2212x1659
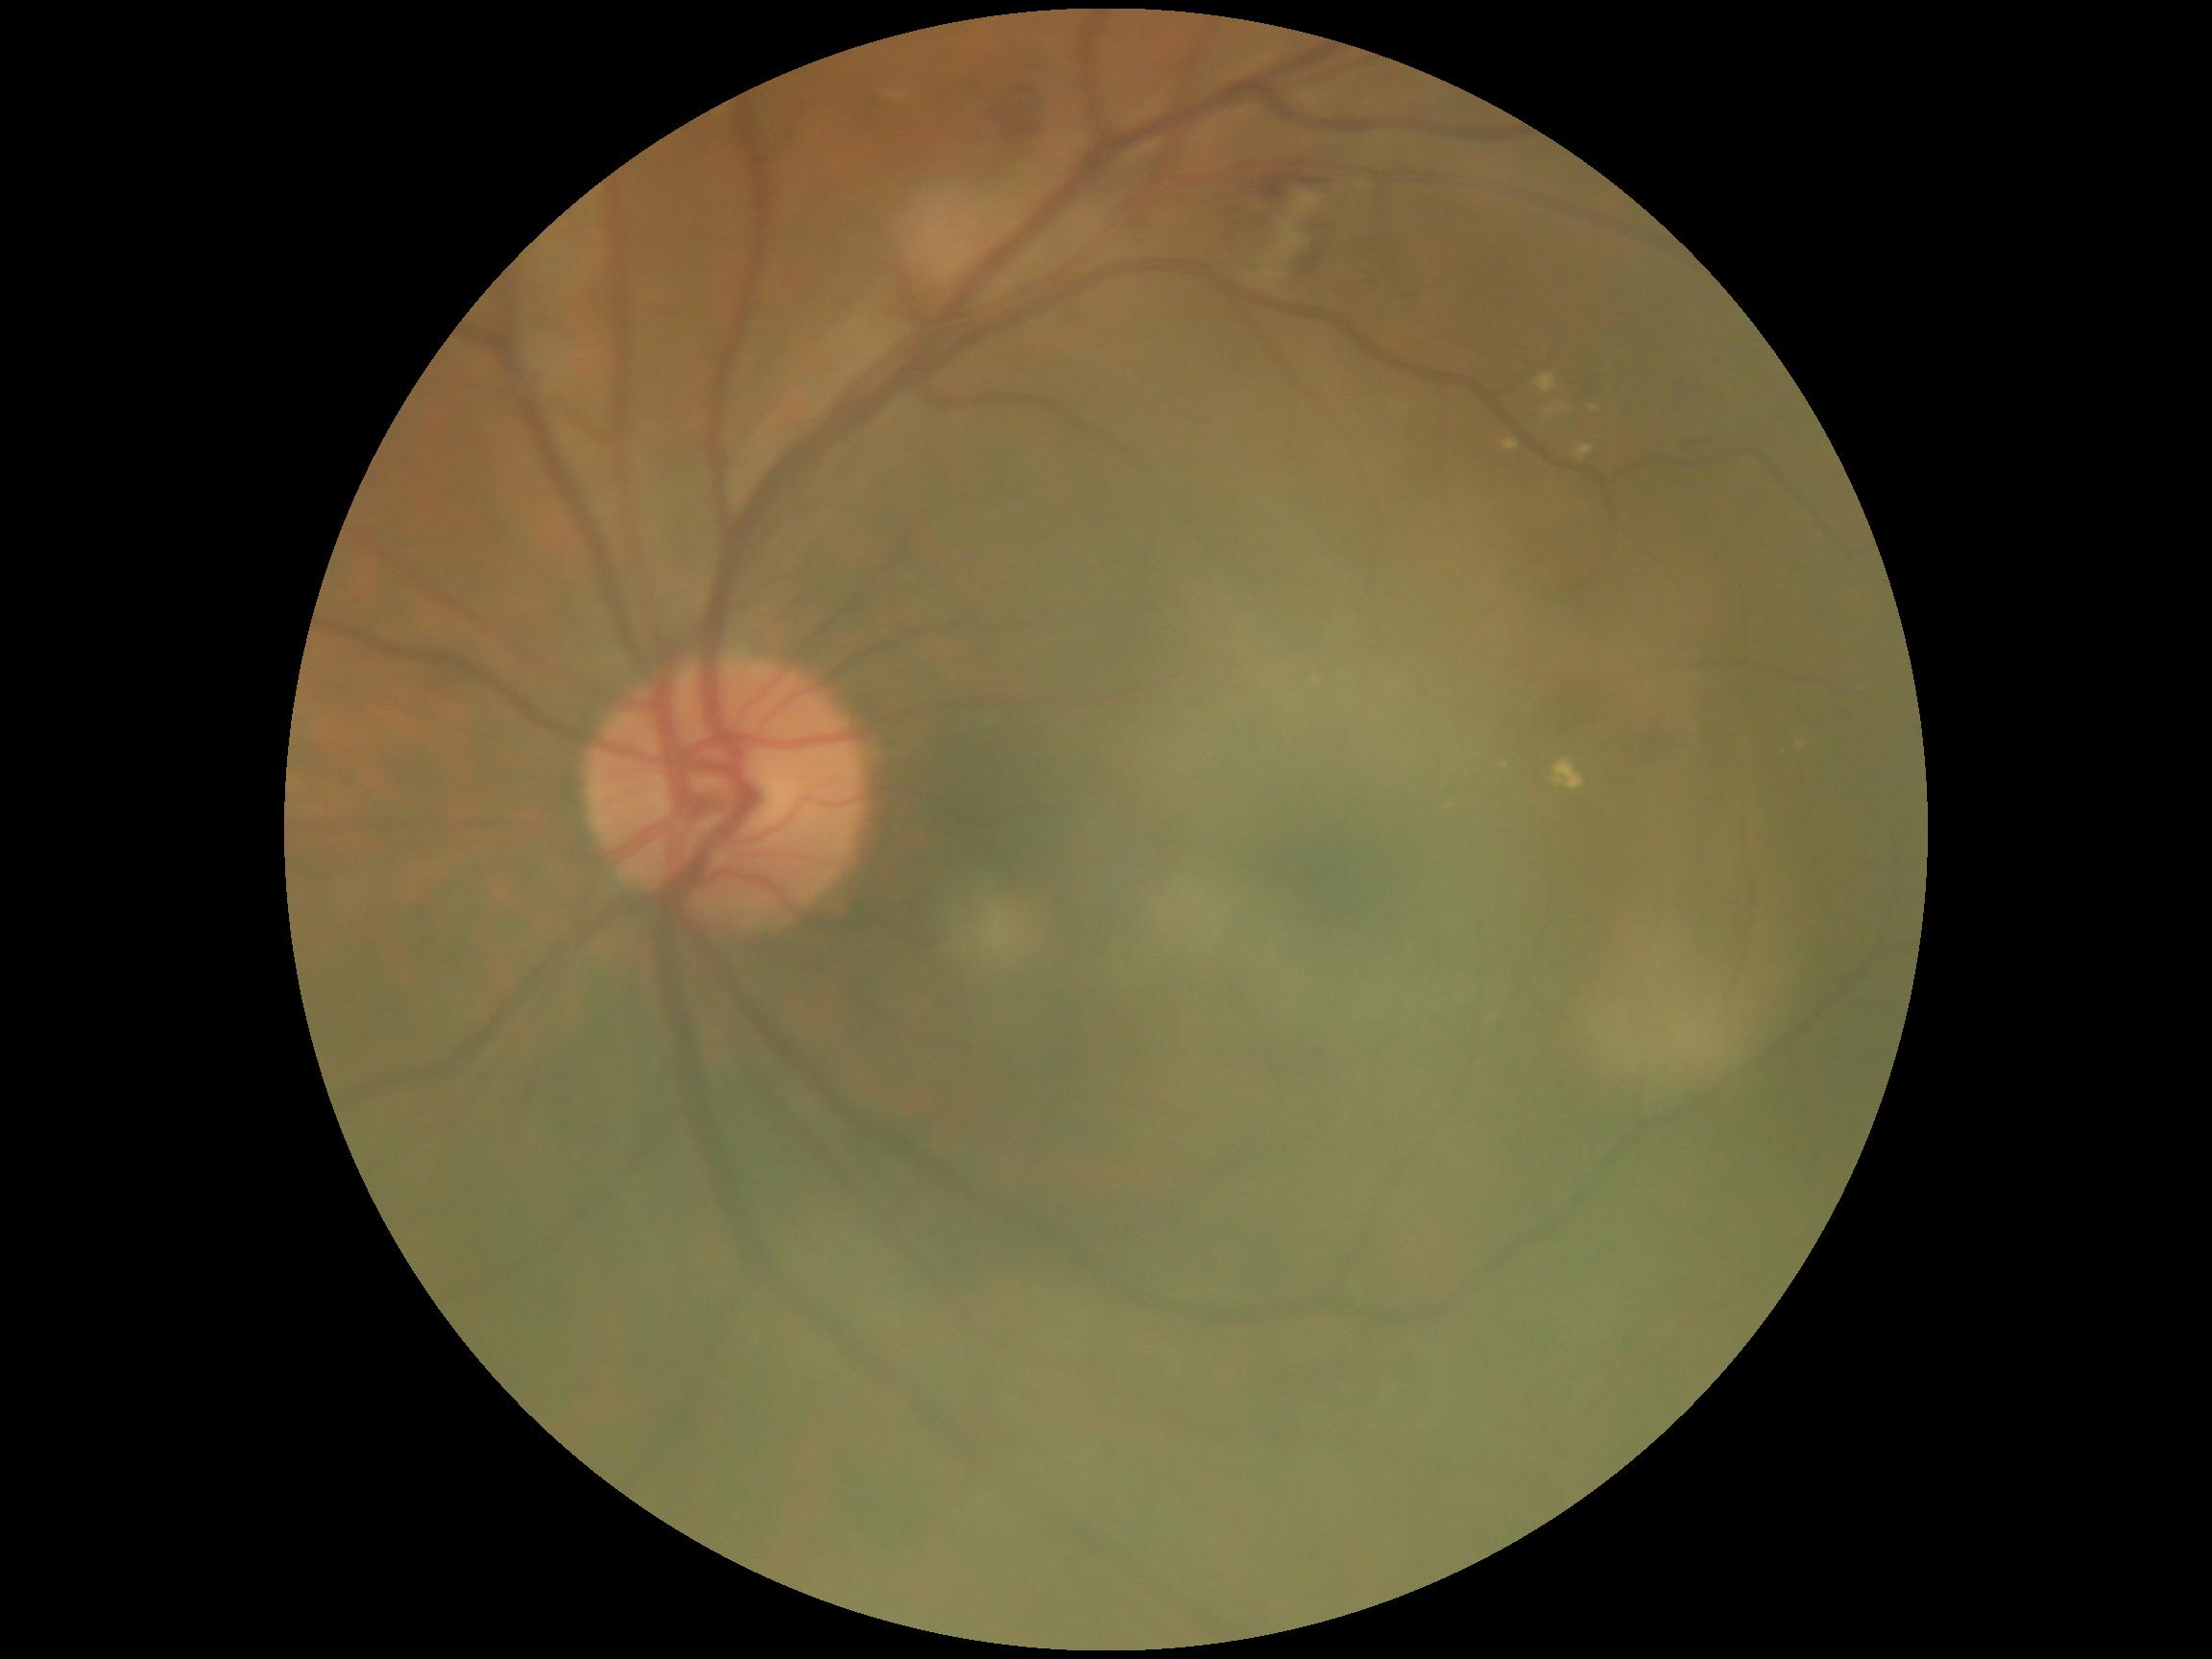
DR stage is grade 2 — more than just microaneurysms but less than severe NPDR.